Wide-field fundus photograph from neonatal ROP screening.
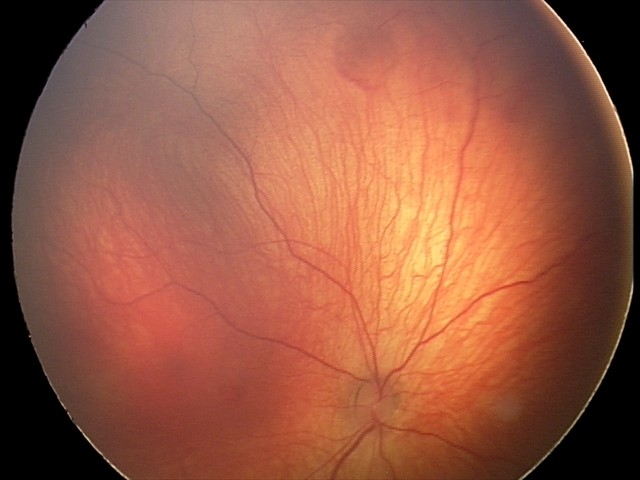
Screening examination consistent with retinal hemorrhages.